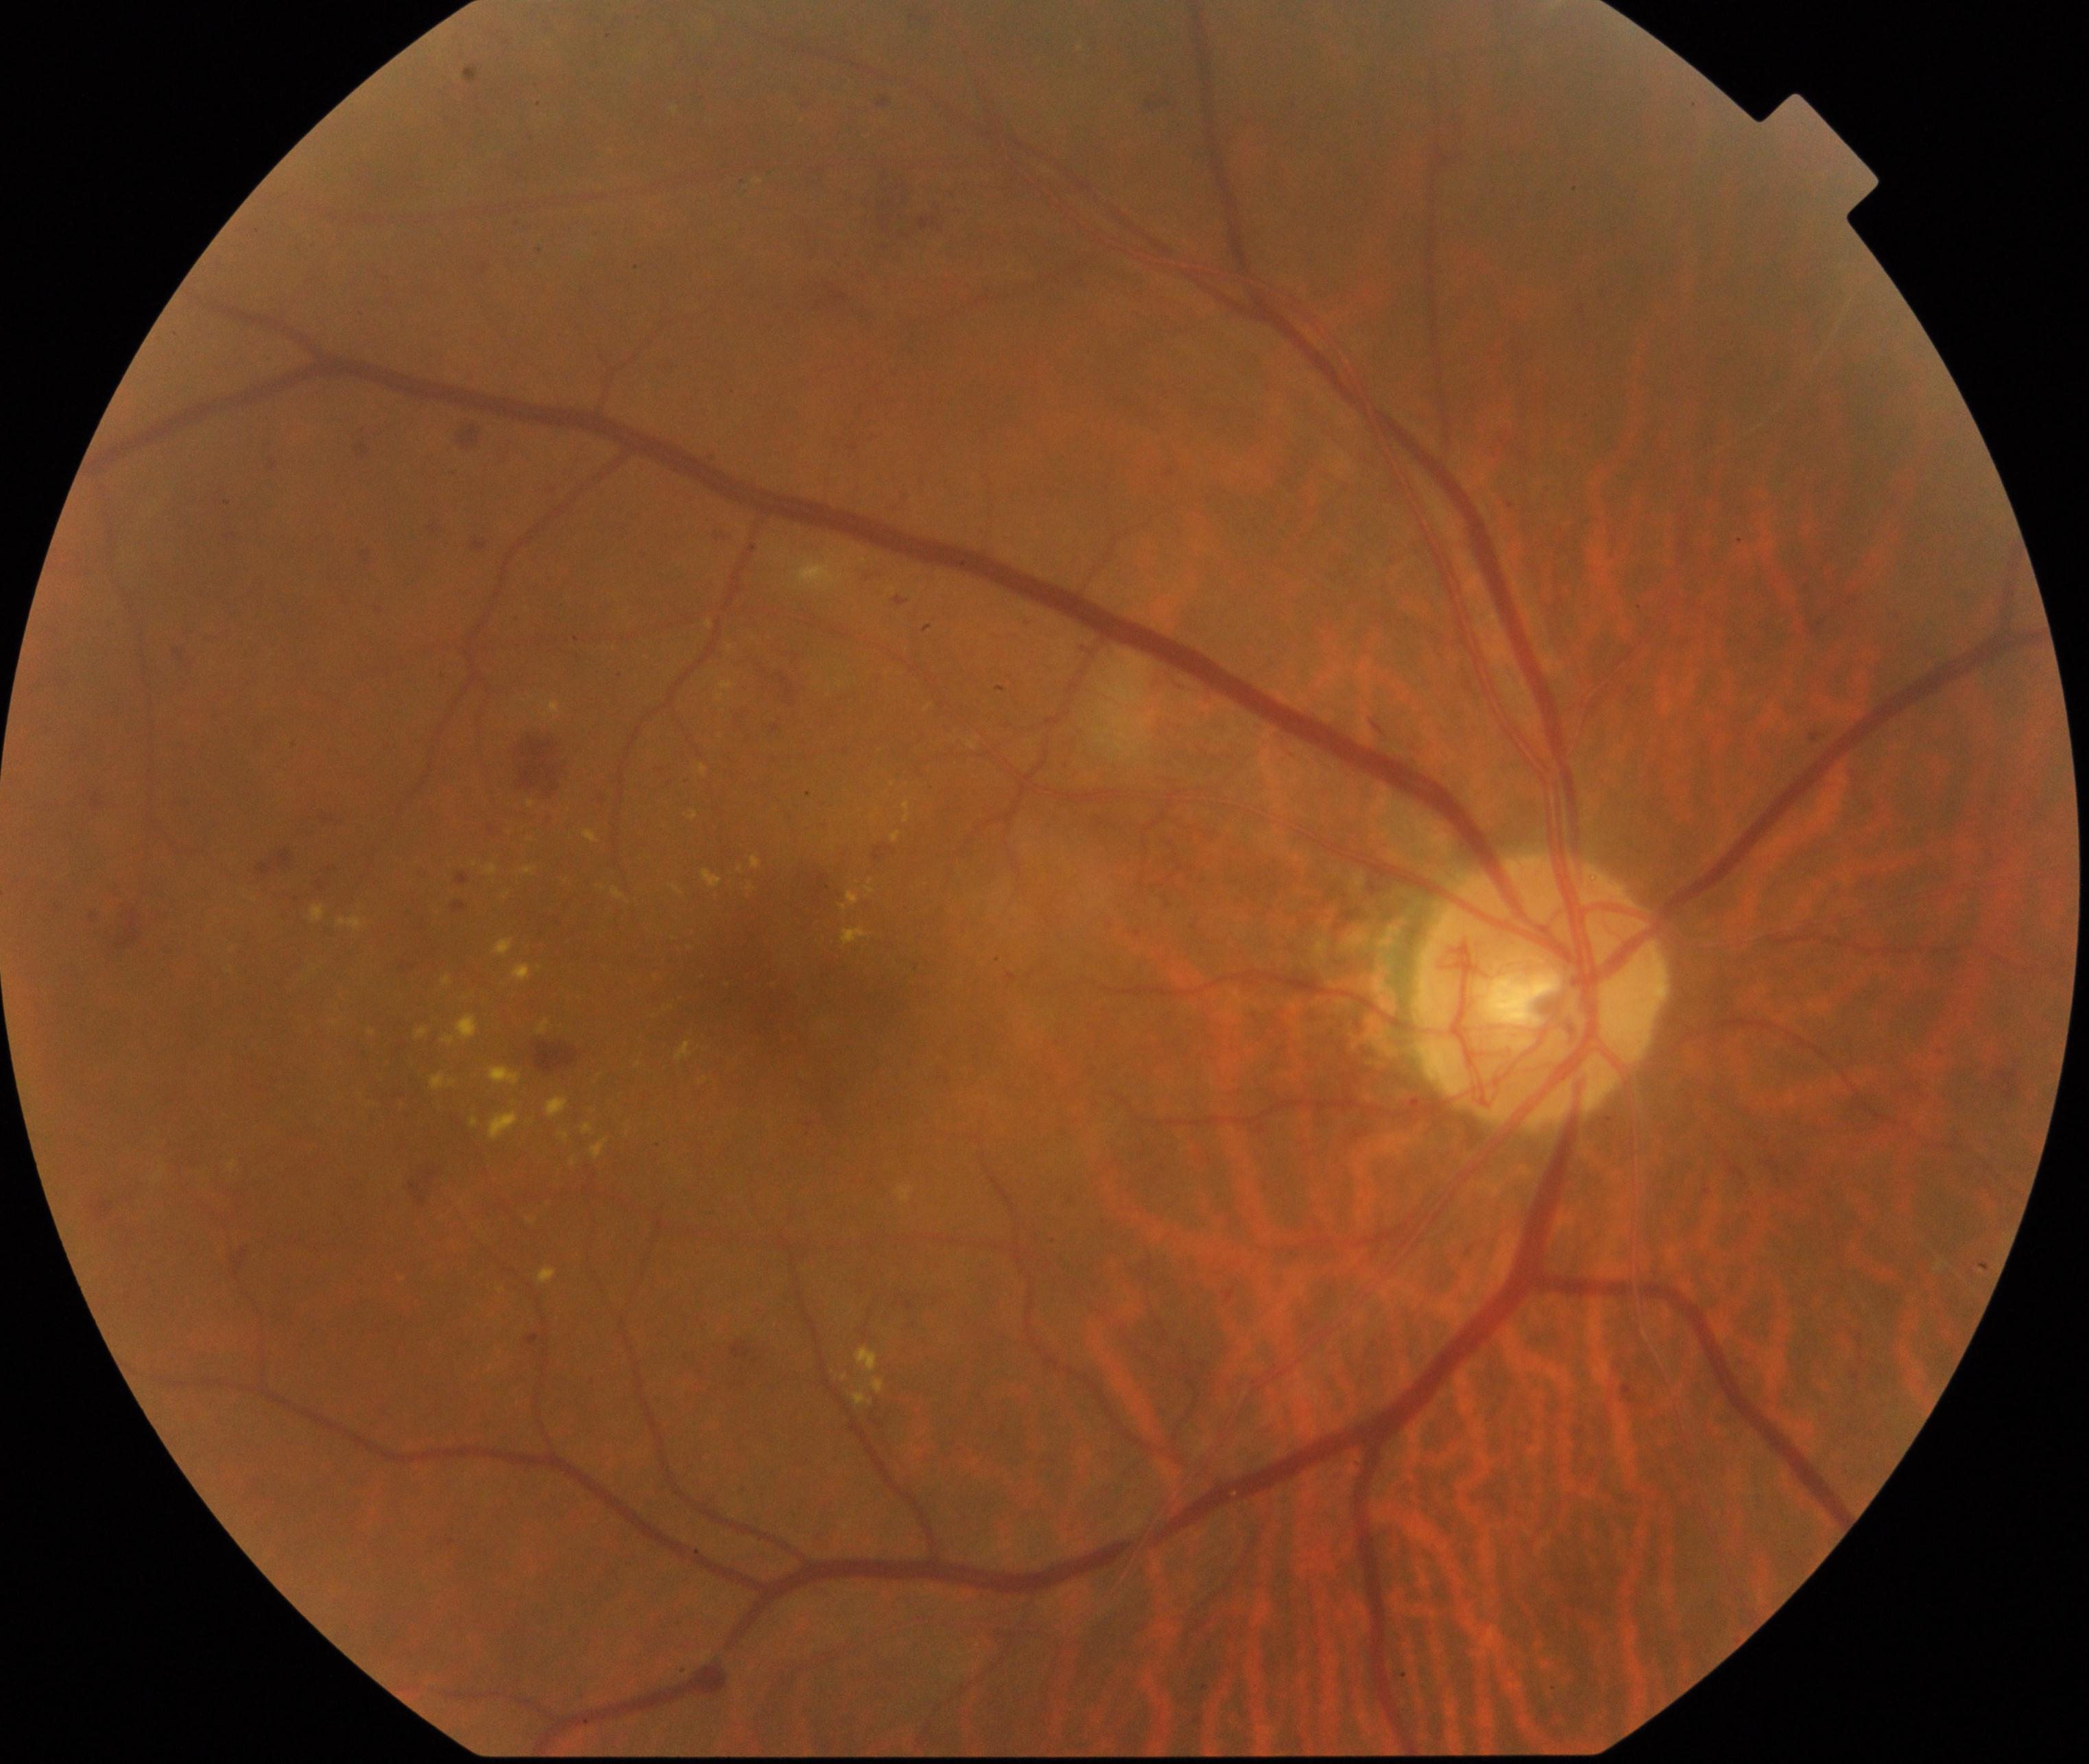
There is evidence of moderate non-proliferative diabetic retinopathy.